Color fundus photograph — 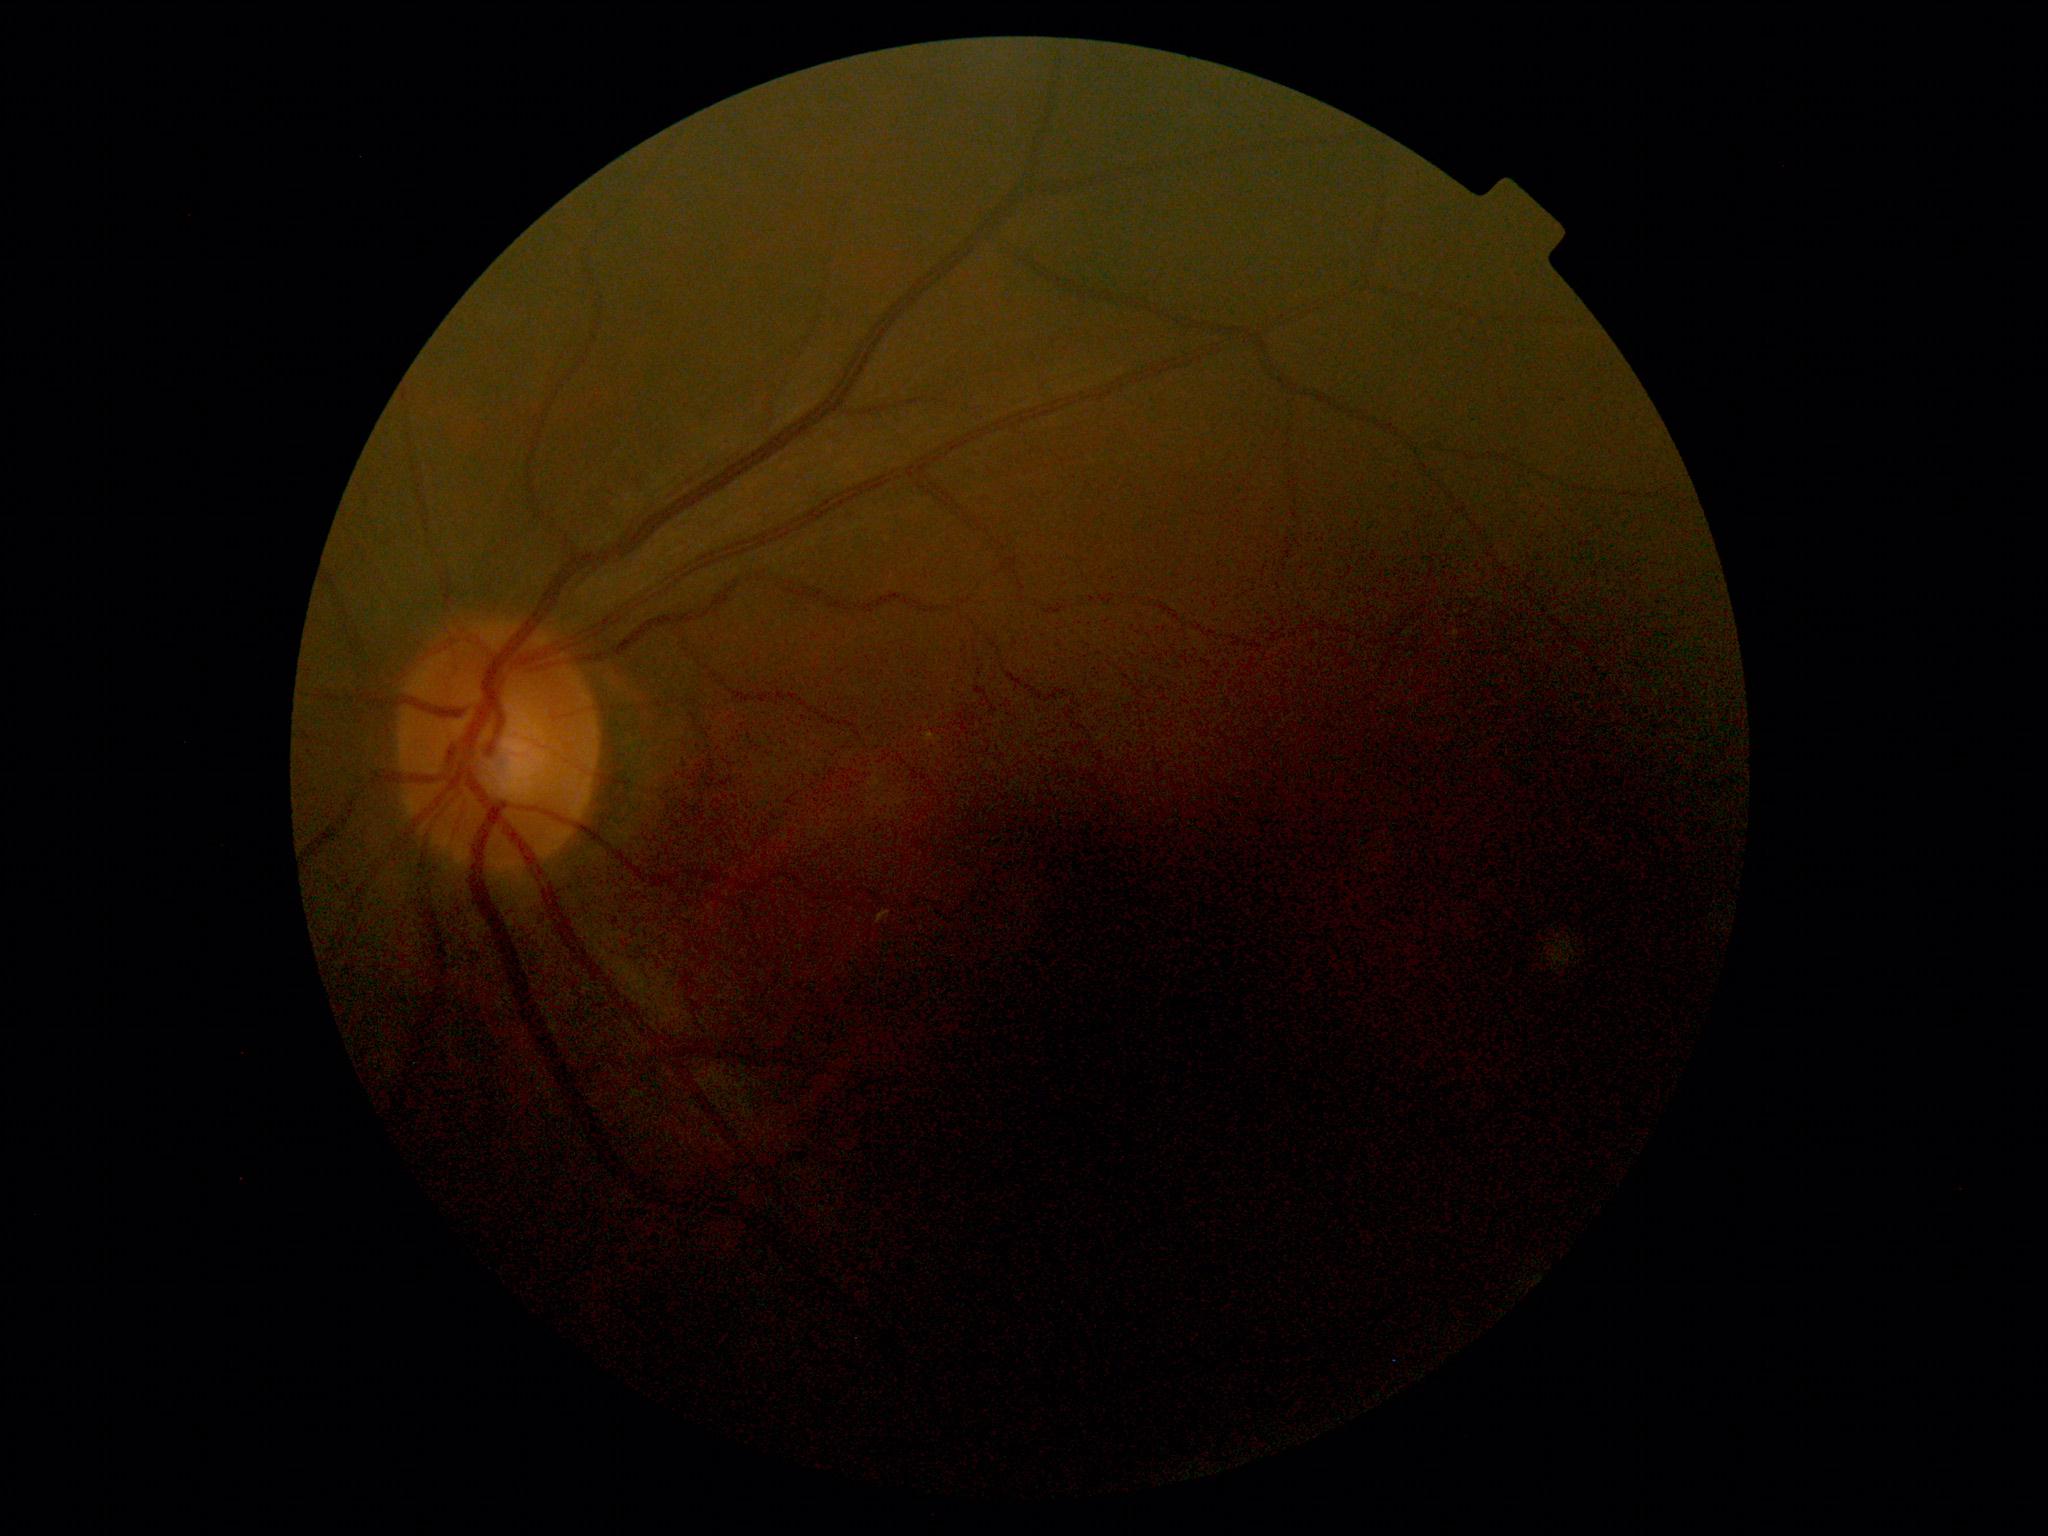
No DR findings.
Diabetic retinopathy grade is no apparent retinopathy (0).